848x848. Color fundus image. NIDEK AFC-230 — 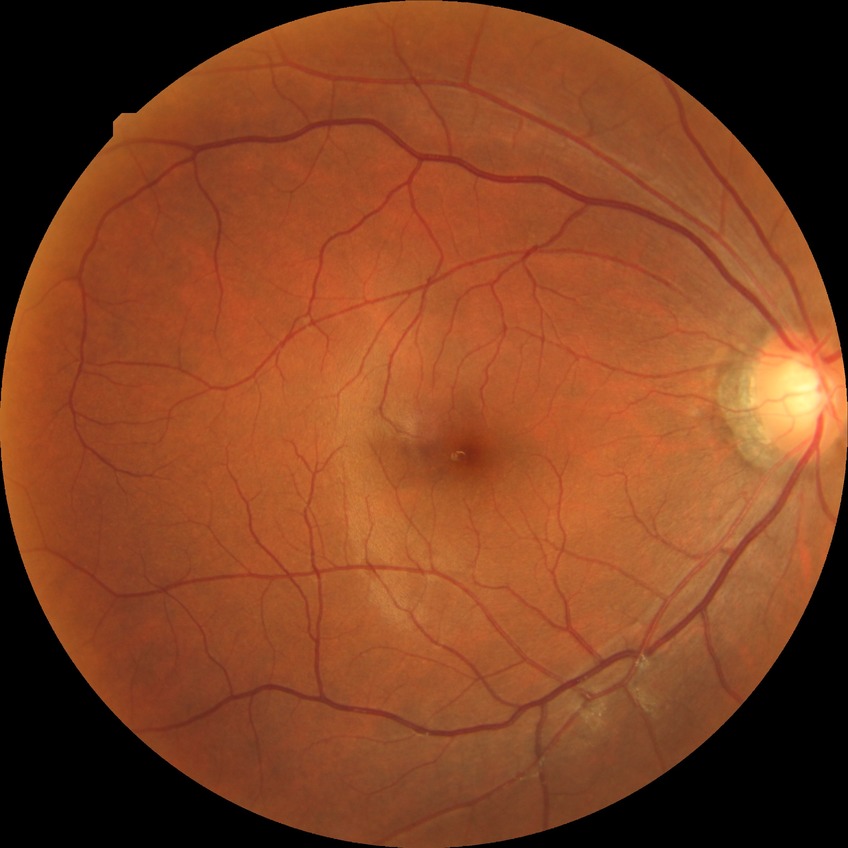 diabetic retinopathy grade: no diabetic retinopathy.